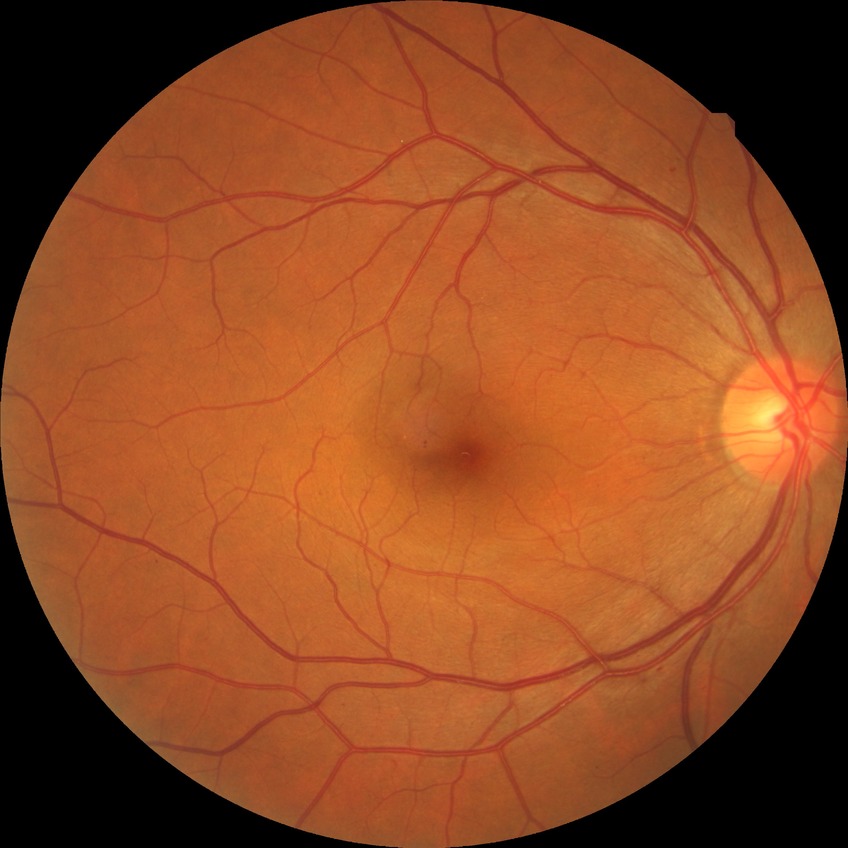

Diabetic retinopathy (DR): no diabetic retinopathy (NDR).